Color fundus photograph — 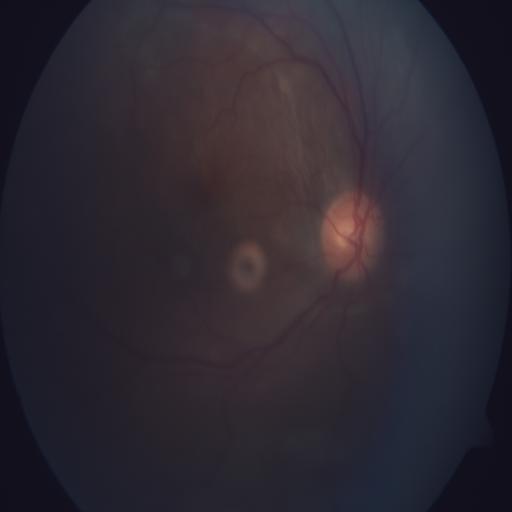
Showing retinal detachment.